Modified Davis grading. No pharmacologic dilation. NIDEK AFC-230 fundus camera. Fundus photo. 45-degree field of view: 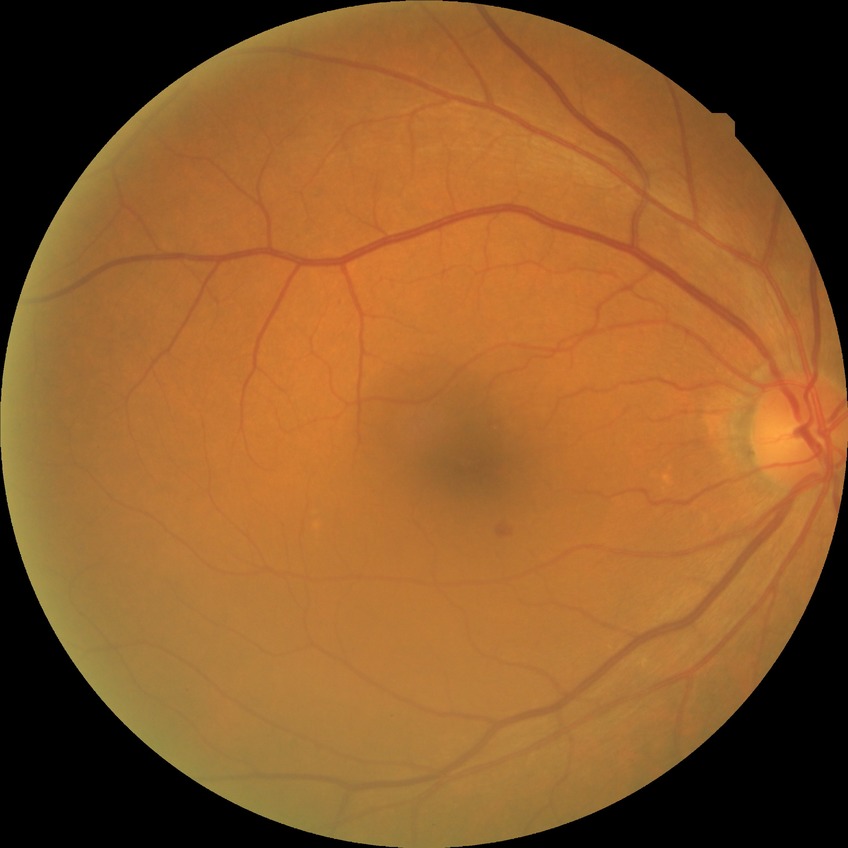
diabetic retinopathy grade: simple diabetic retinopathy.